CFP; nonmydriatic; modified Davis grading.
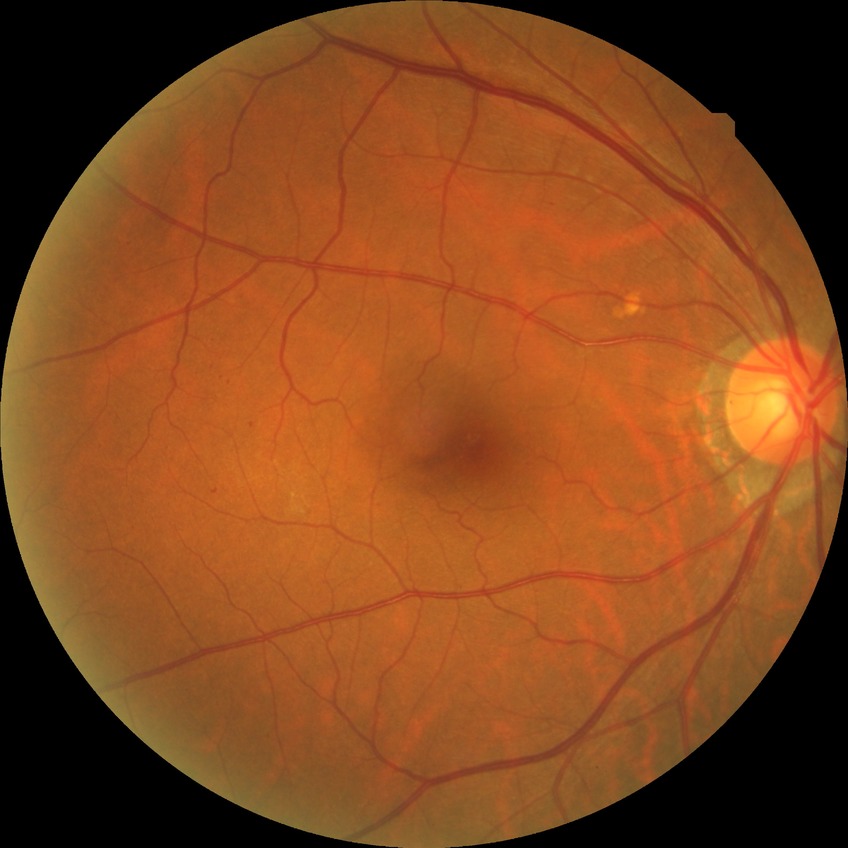

Diabetic retinopathy grade is simple diabetic retinopathy.